Graded on the modified Davis scale · FOV: 45 degrees · no pharmacologic dilation:
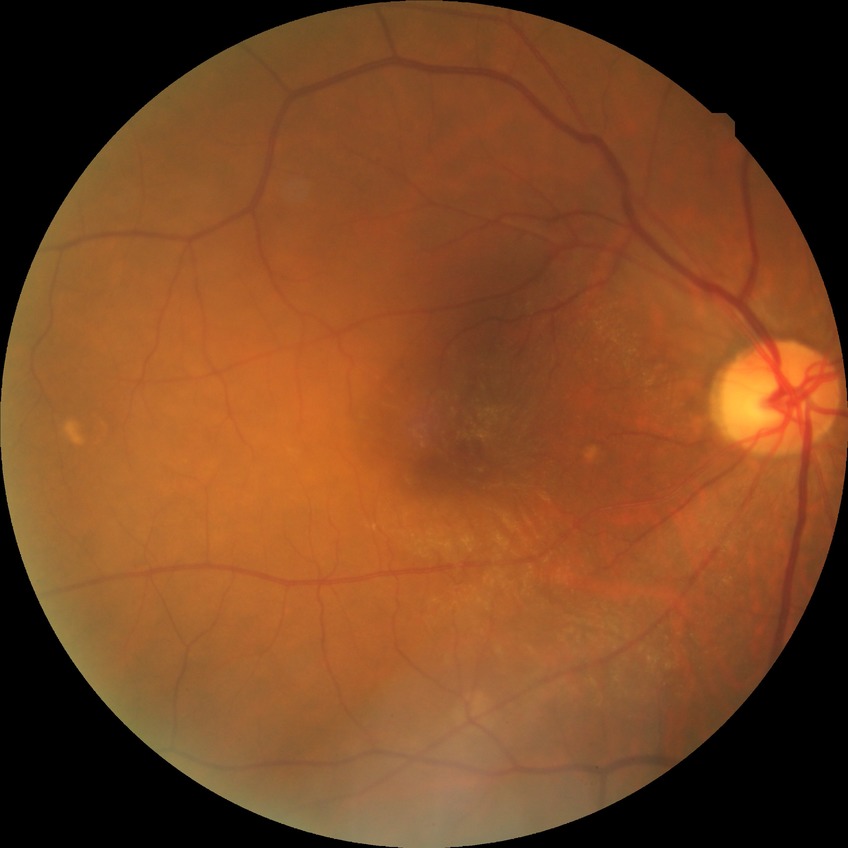 Retinopathy grade is no diabetic retinopathy.